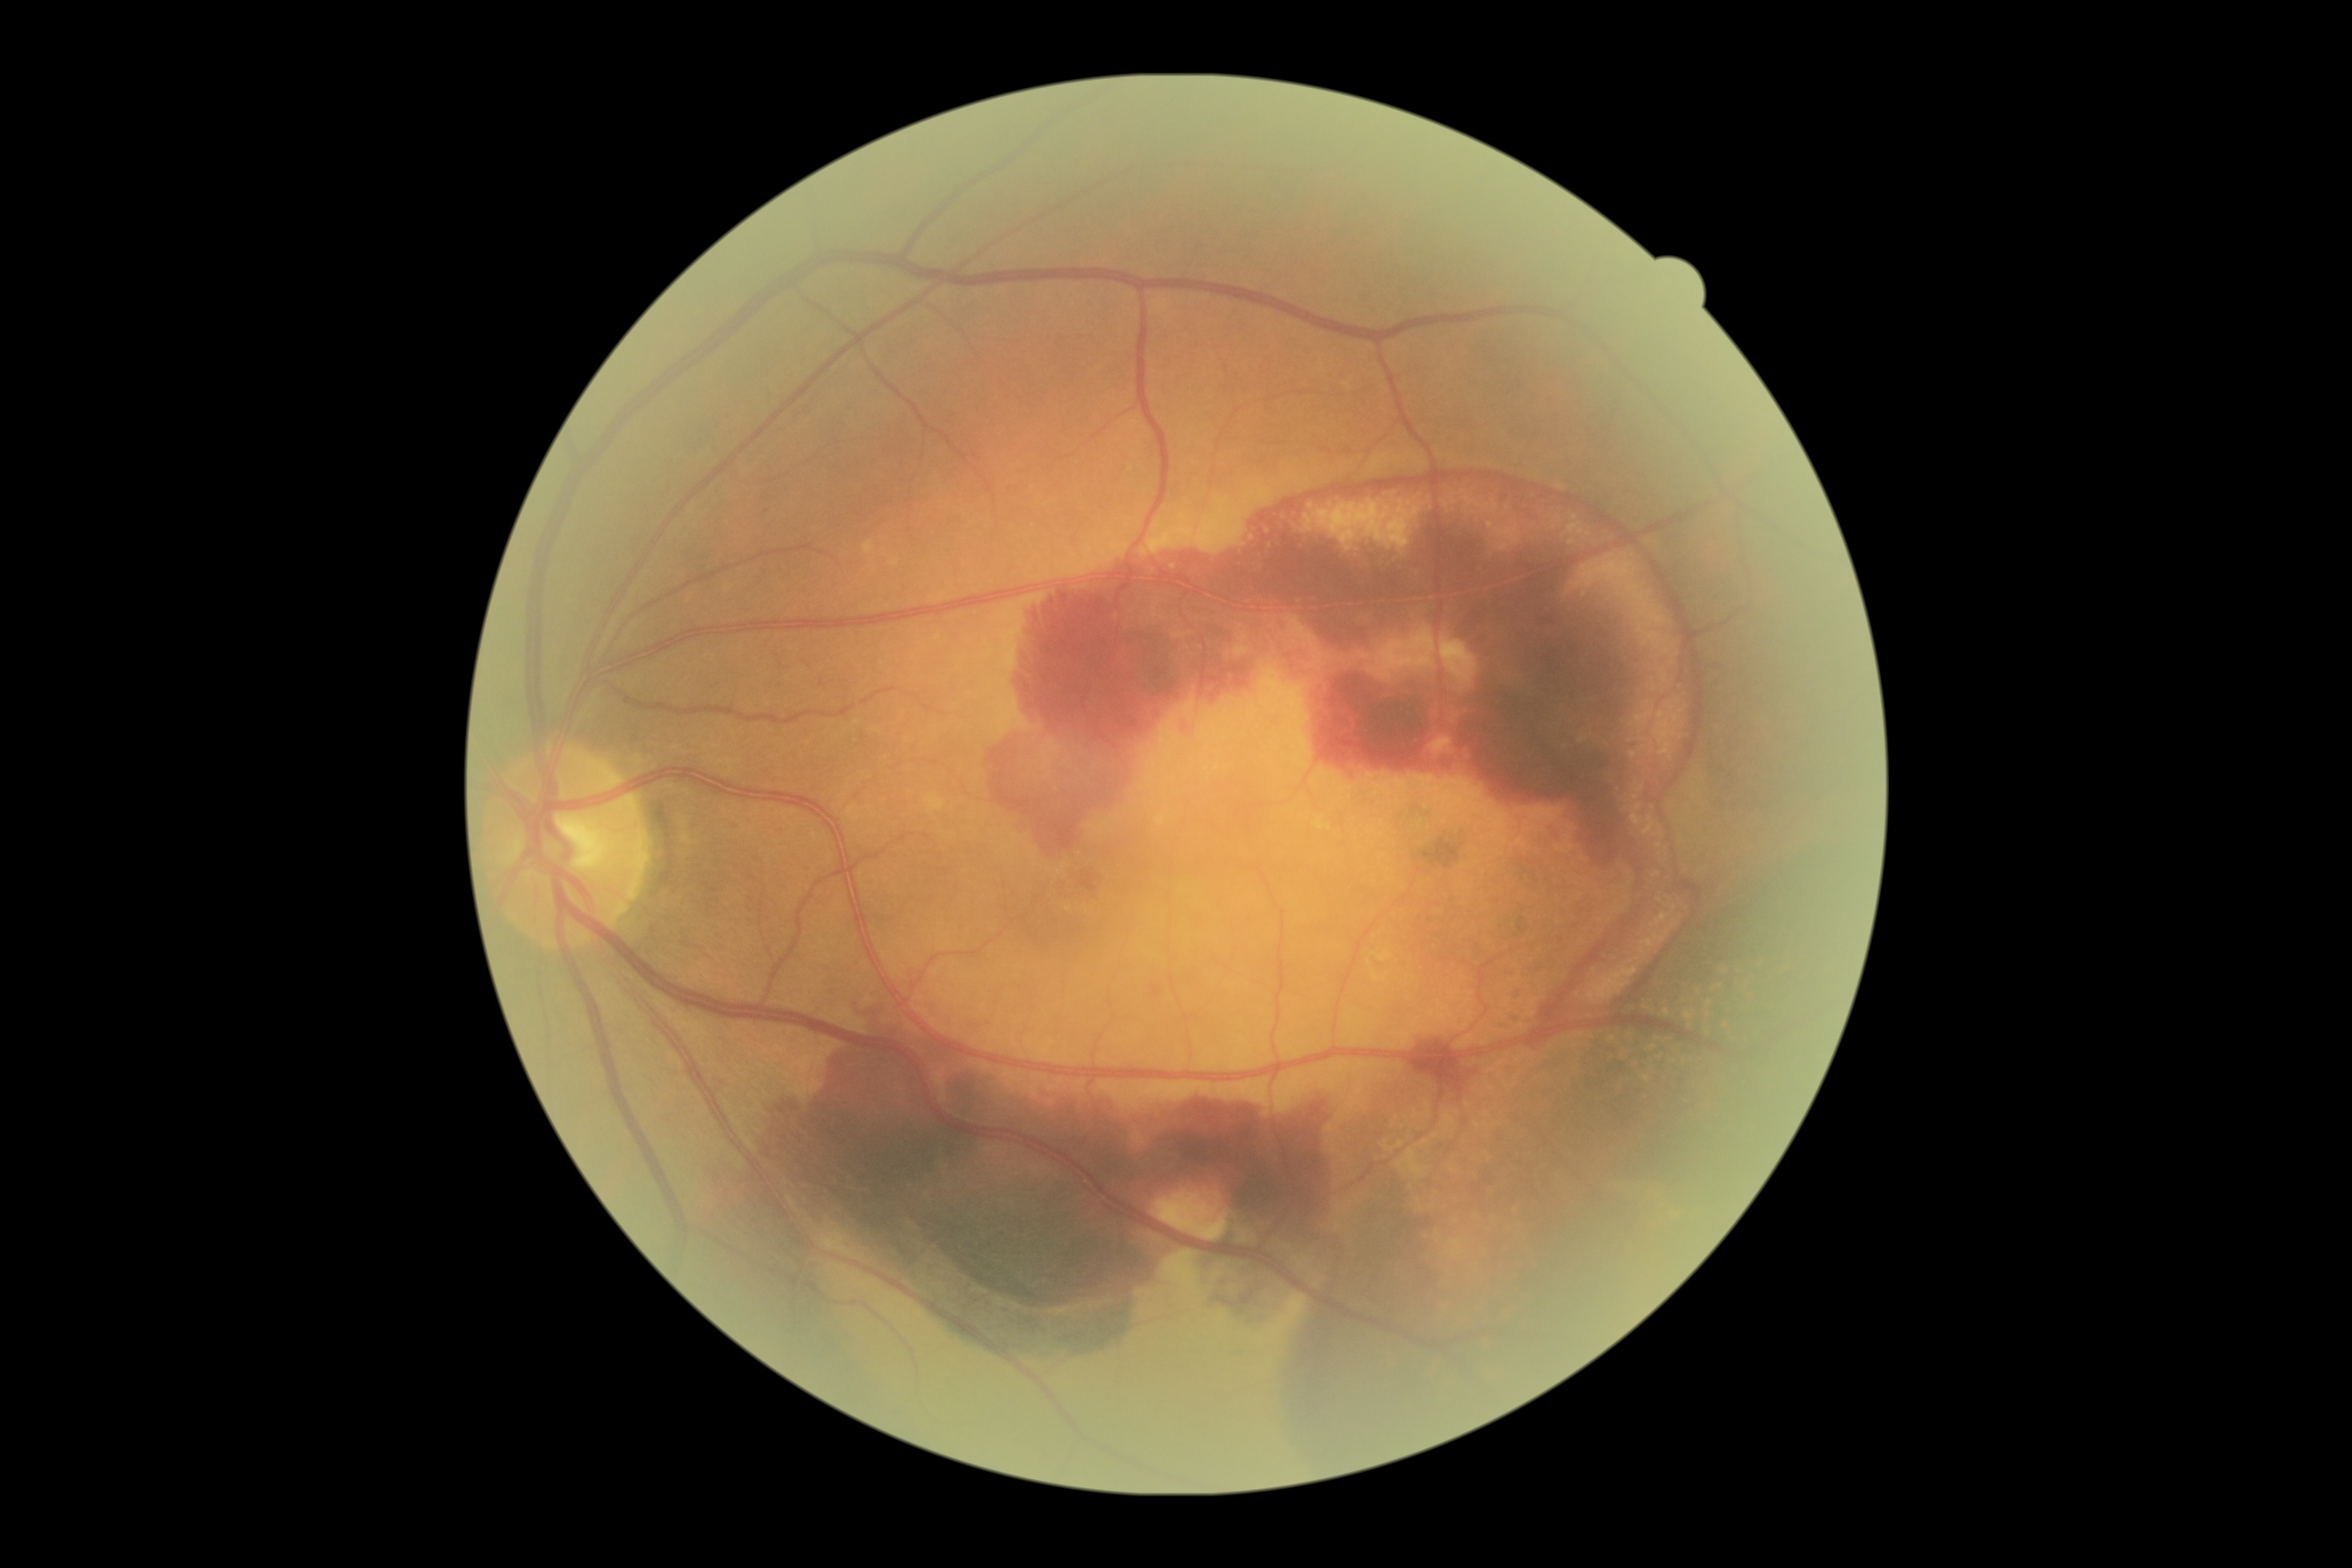

DR grade = 4.